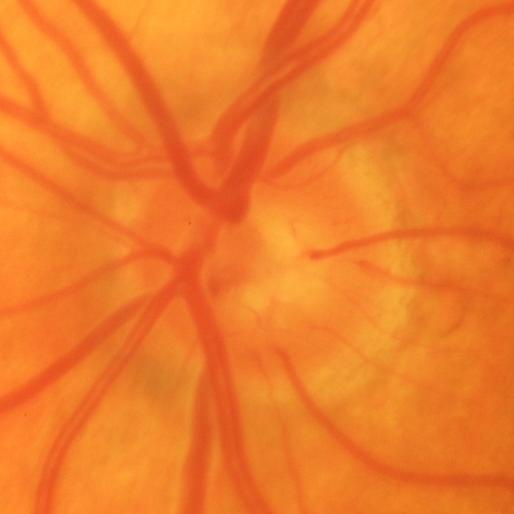
Impression: evidence of glaucoma.